Wide-field fundus photograph of an infant
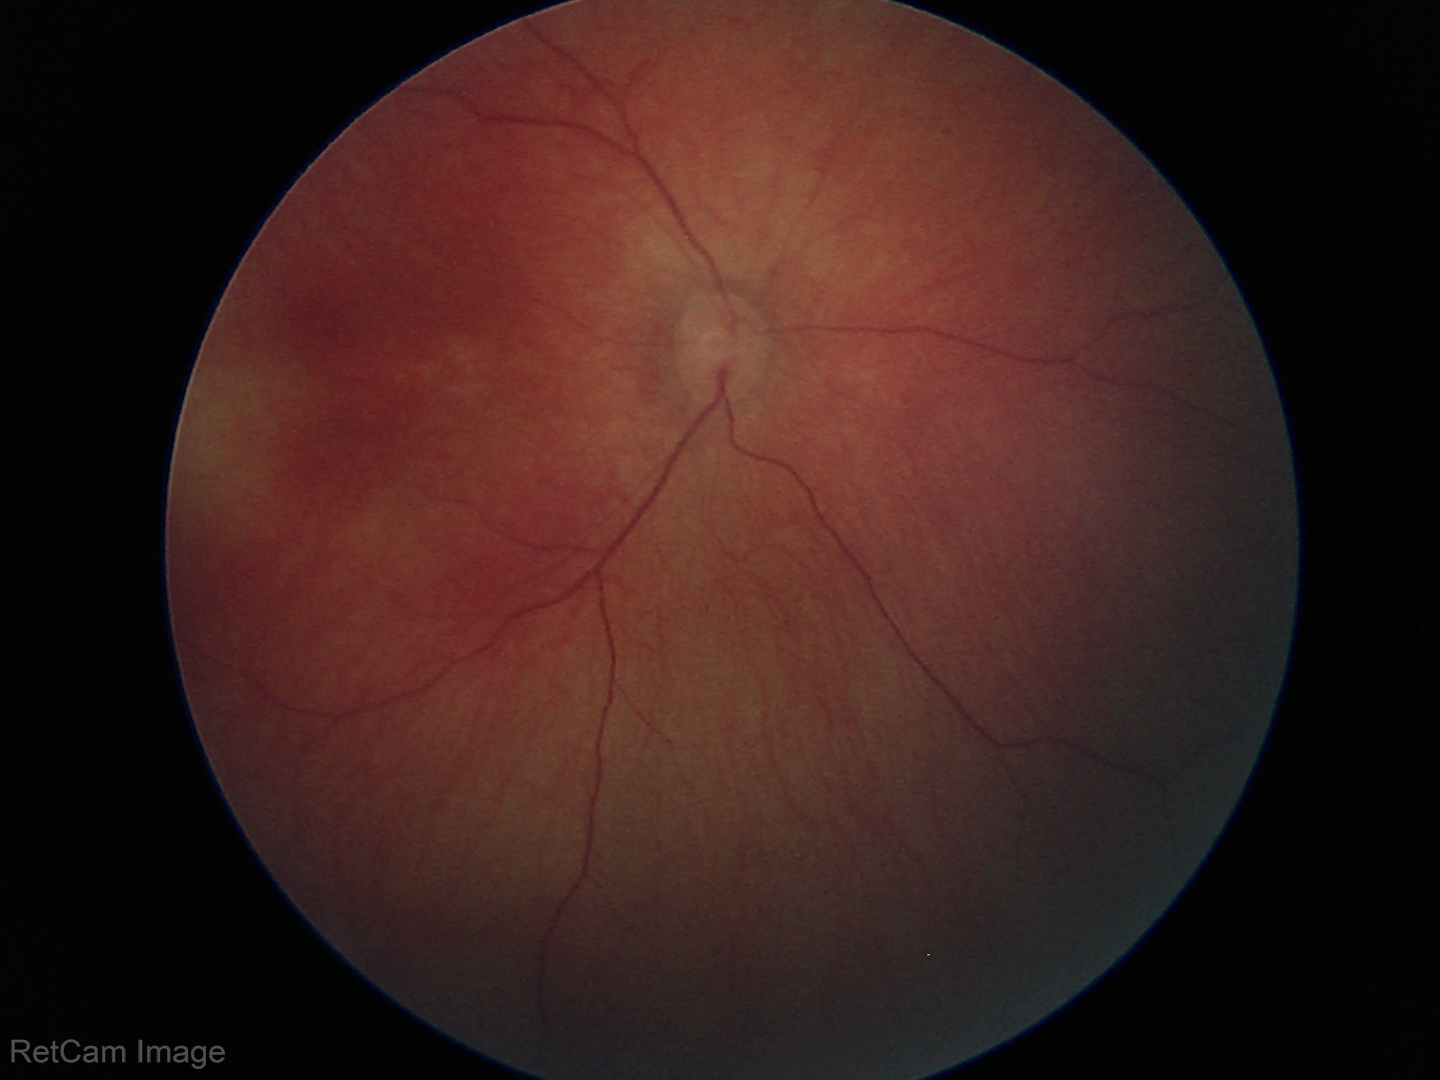 Impression: physiological retinal finding.